Color fundus image
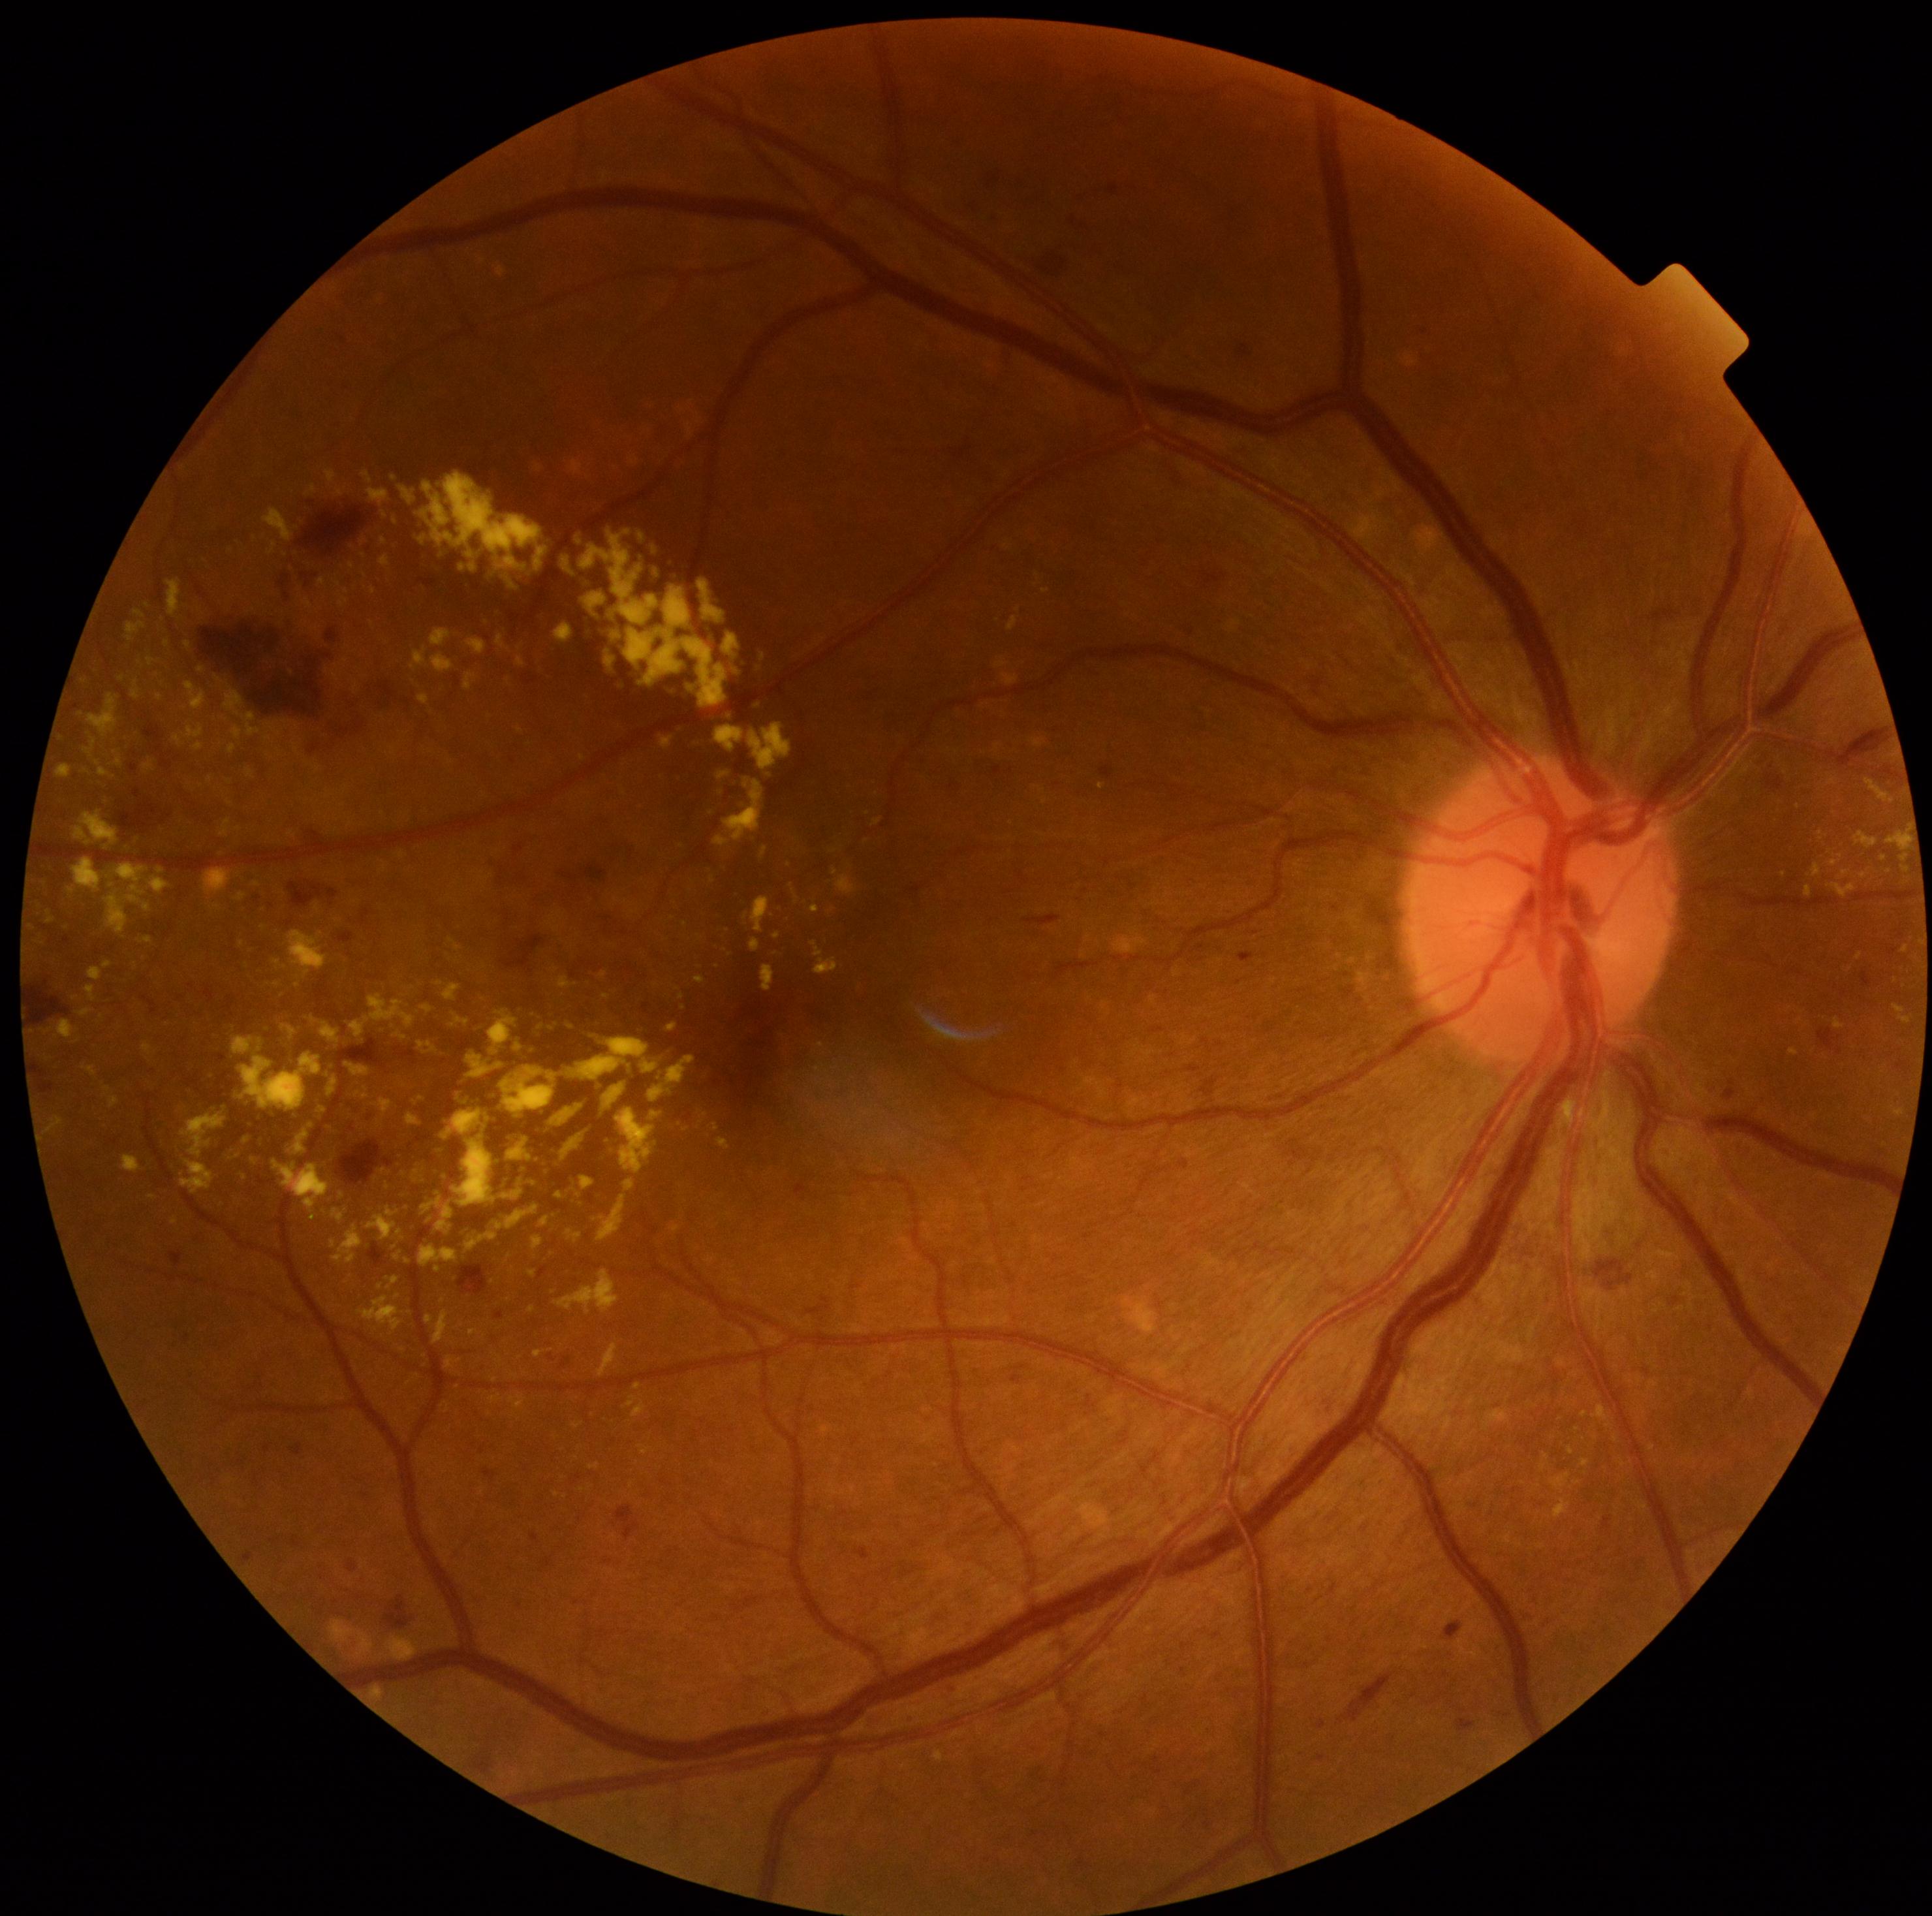

Retinopathy grade: 2
Selected lesions:
hard exudates (more not shown): <bbox>1828, 777, 1837, 786</bbox>; <bbox>1865, 778, 1892, 803</bbox>; <bbox>387, 1277, 399, 1290</bbox>; <bbox>529, 1270, 537, 1277</bbox>; <bbox>456, 1017, 469, 1025</bbox>; <bbox>1904, 945, 1909, 954</bbox>; <bbox>1856, 832, 1878, 850</bbox>; <bbox>535, 1351, 544, 1359</bbox>; <bbox>420, 695, 430, 706</bbox>; <bbox>326, 469, 337, 486</bbox>; <bbox>319, 577, 326, 586</bbox>; <bbox>87, 693, 119, 739</bbox>; <bbox>495, 633, 511, 652</bbox>
Small hard exudates near 1615:1439; 487:622; 409:1262; 291:835; 554:970; 166:644